Retinal fundus photograph, 45-degree field of view, 2346x1568
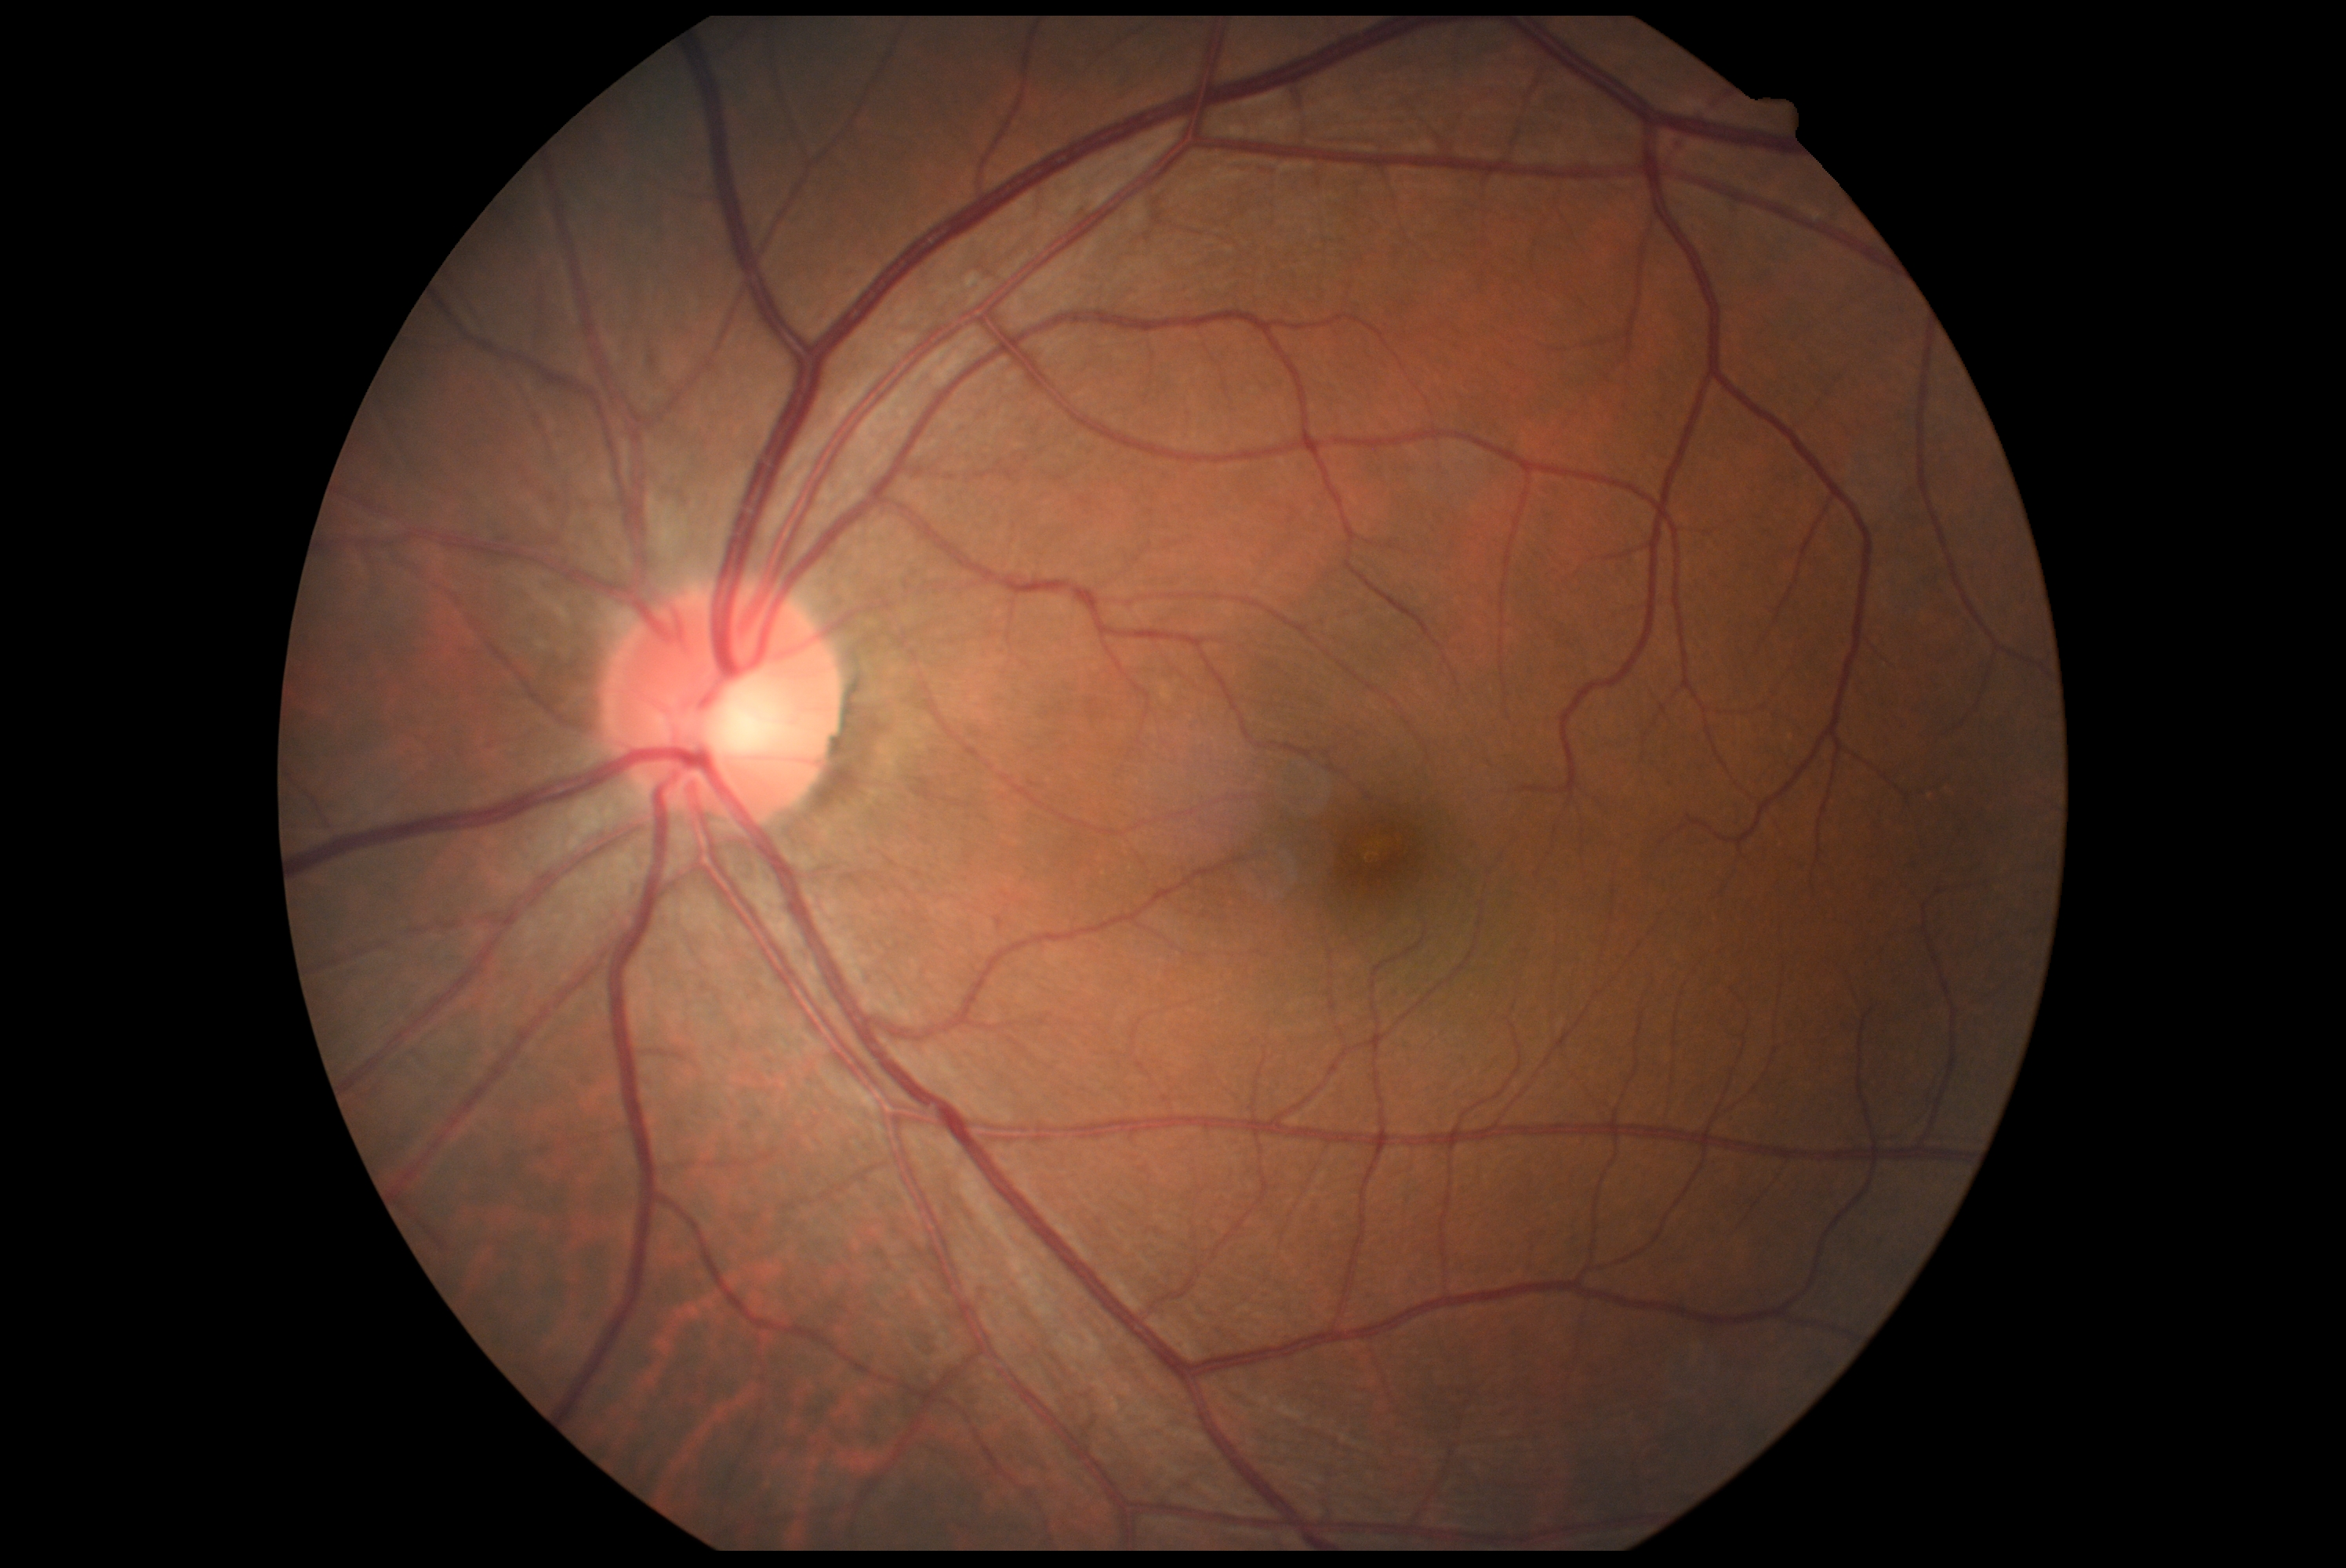
Diabetic retinopathy (DR): no apparent retinopathy (grade 0).